848x848 · 45 degree fundus photograph · color fundus image · no pharmacologic dilation — 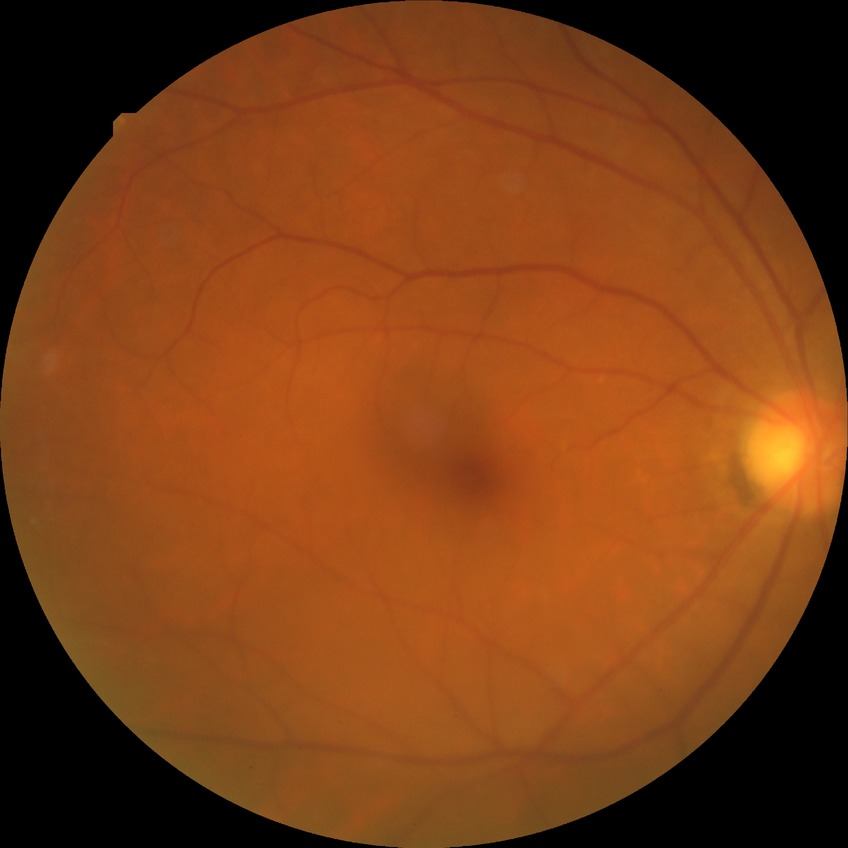

diabetic retinopathy (DR): no diabetic retinopathy (NDR).